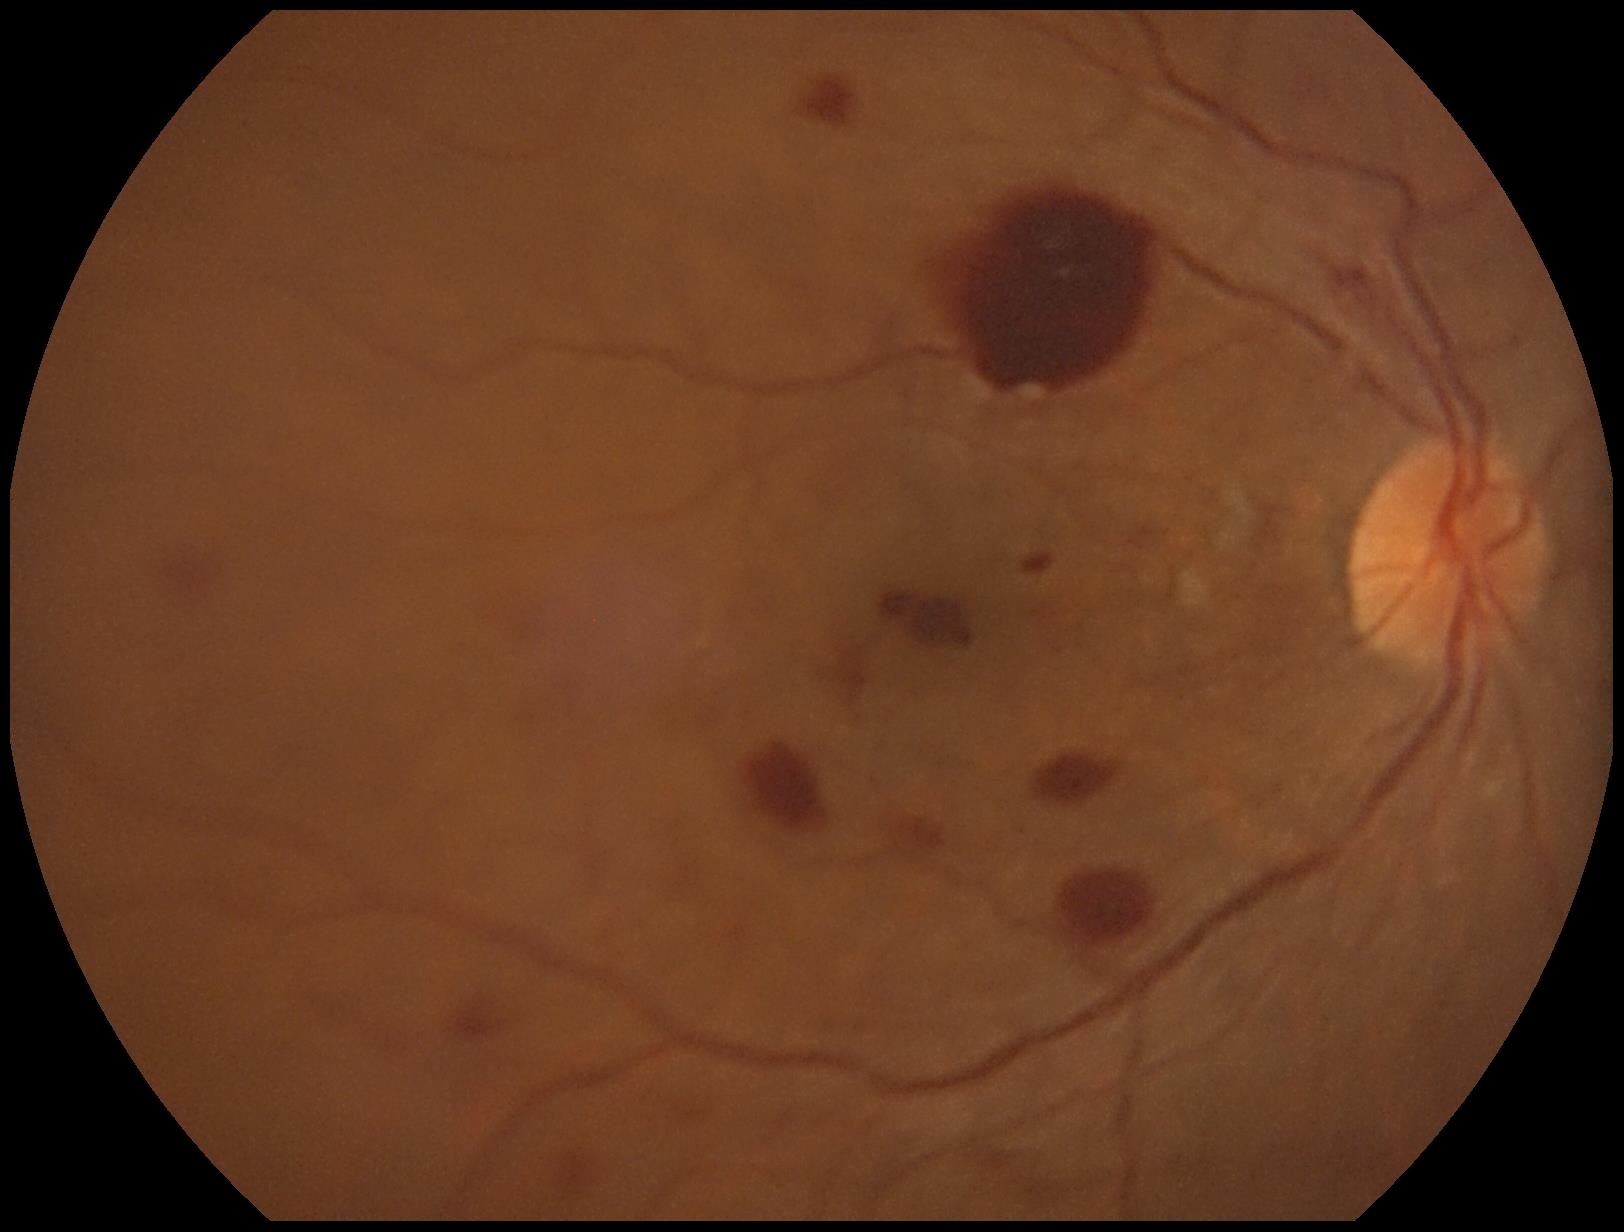

DR class: proliferative diabetic retinopathy; DR severity: grade 4 (PDR).